Image size 640x480; wide-field fundus image from infant ROP screening — 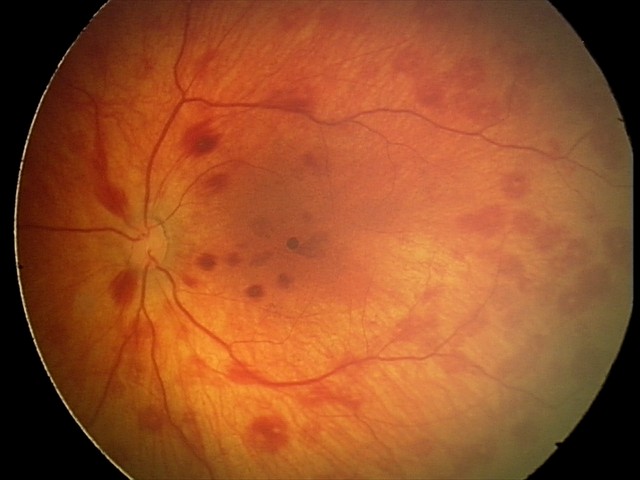

Q: What was the screening finding?
A: retinal hemorrhages